Pupil-dilated.
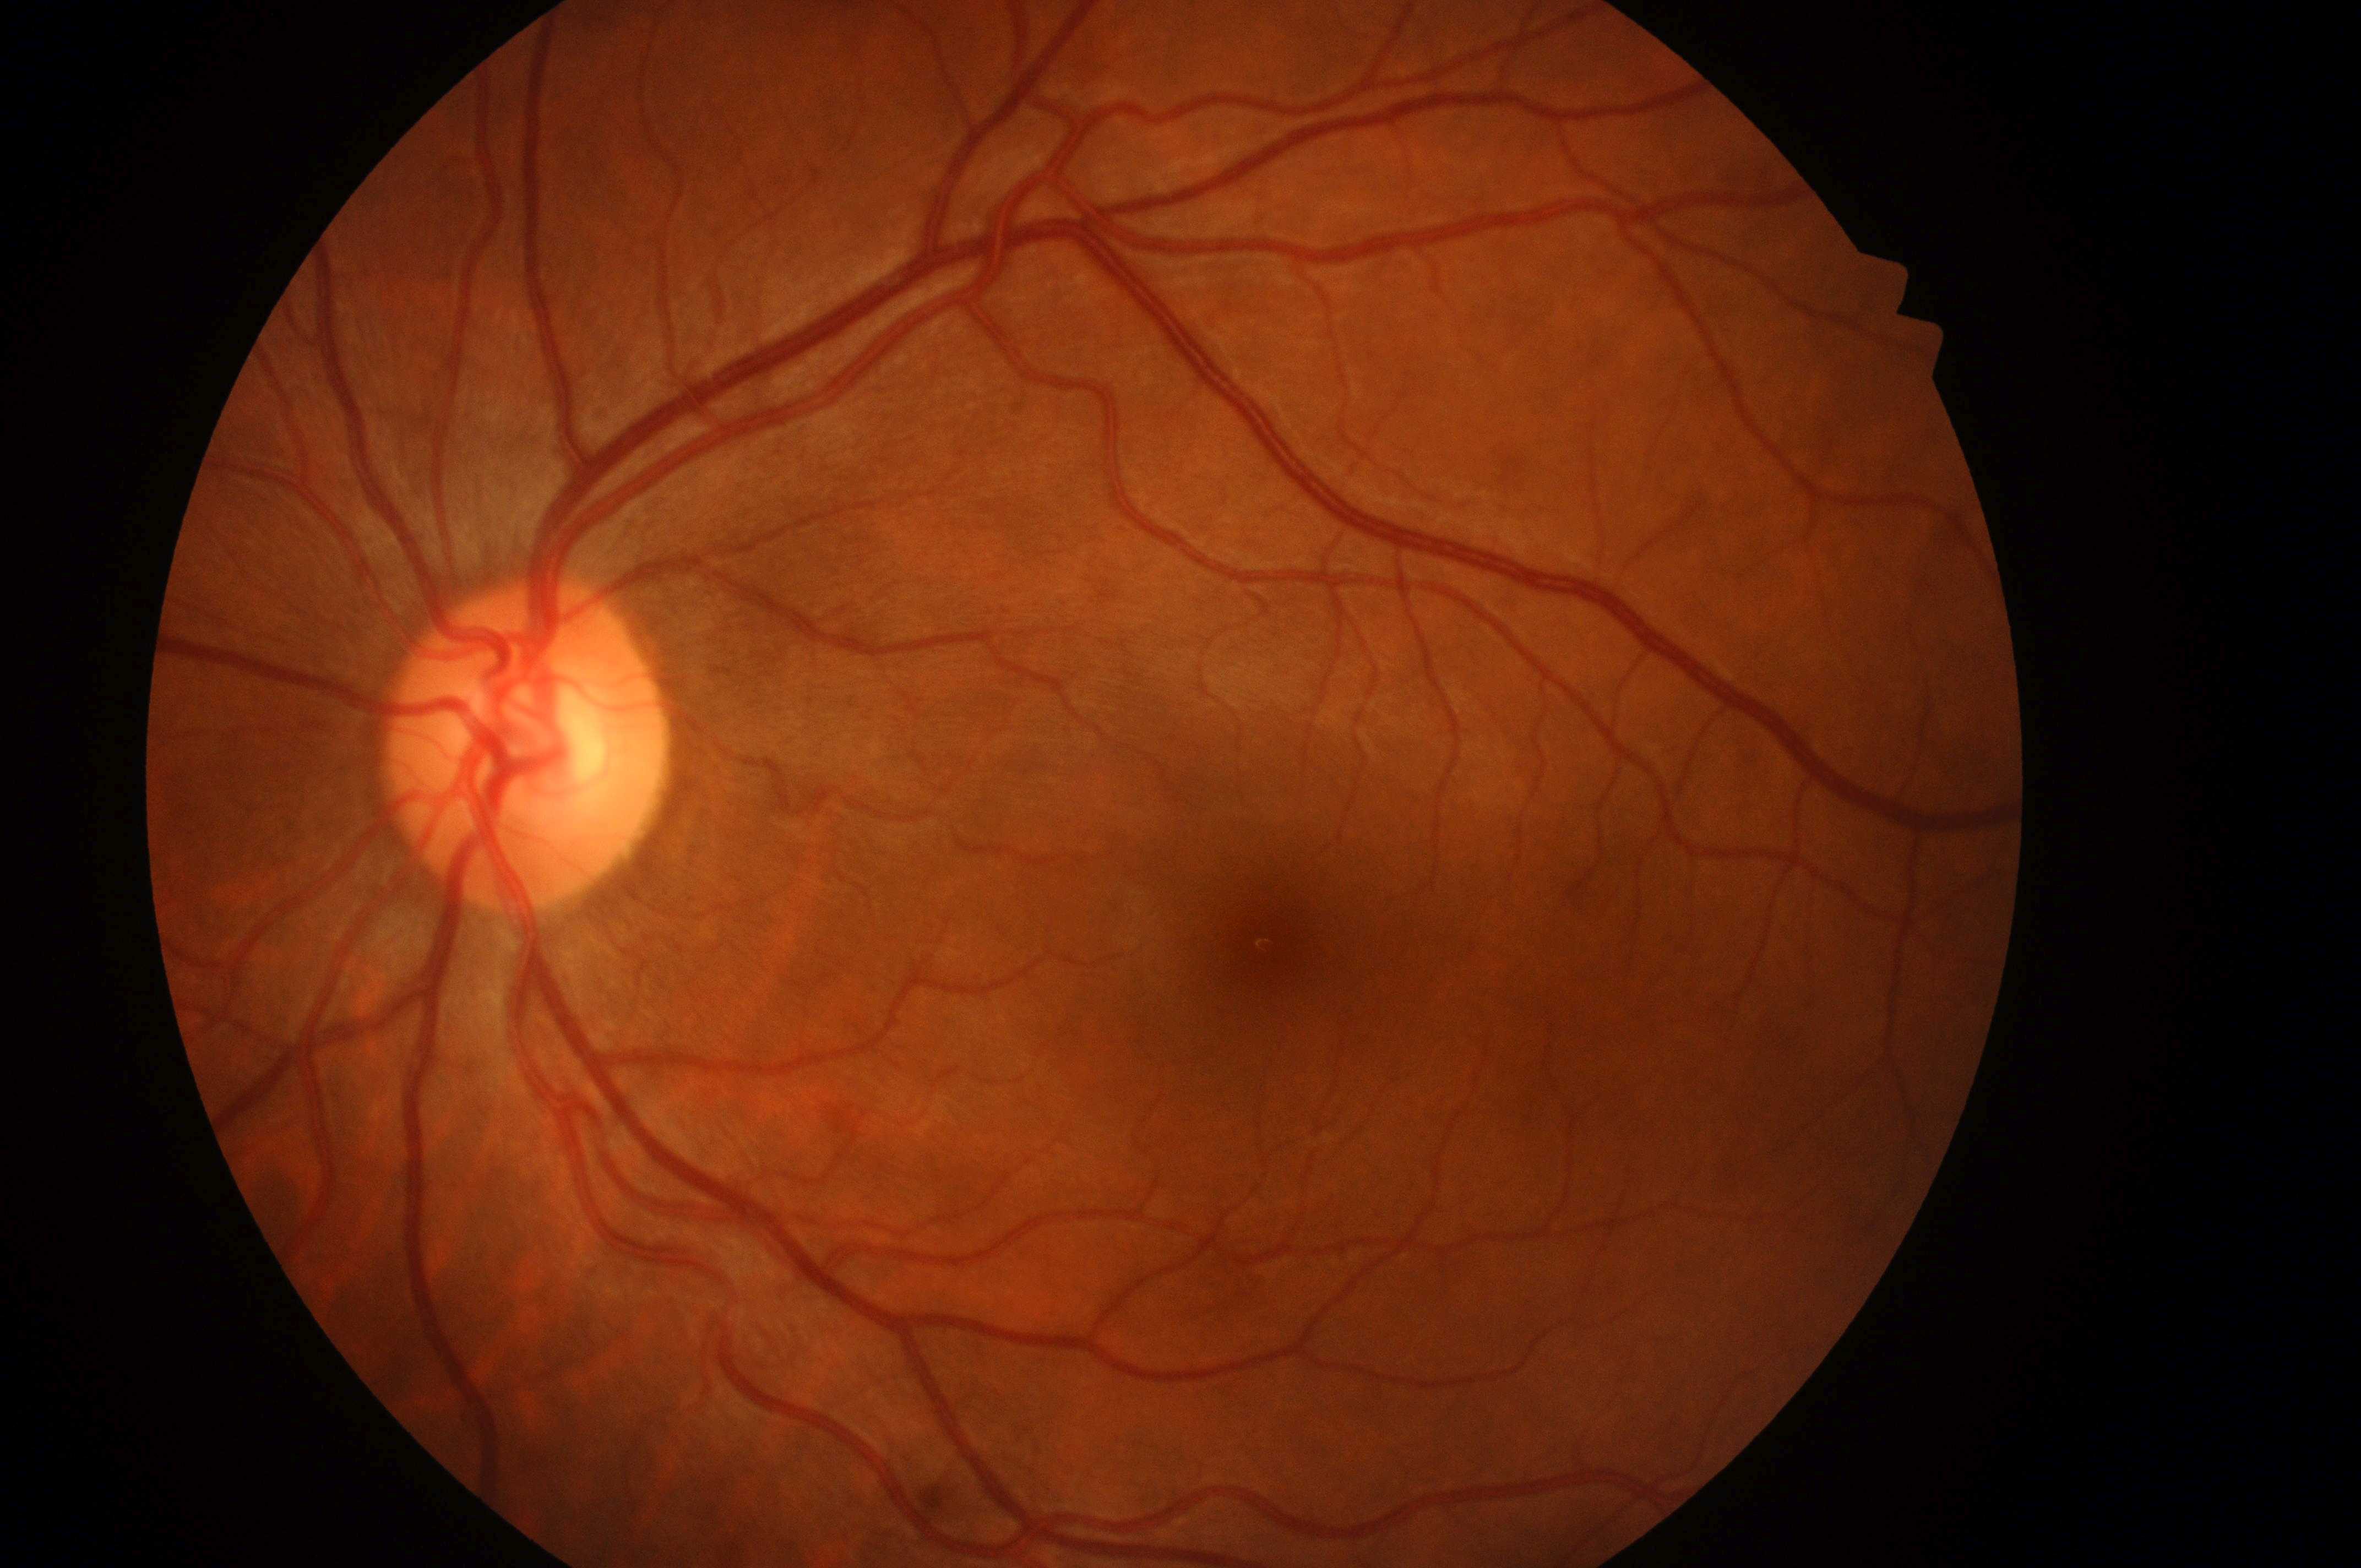
risk of macular edema = grade 0 (no risk); laterality = oculus sinister; optic disc center = [518, 759]; fovea centralis = [1277, 946]; DR impression = No diabetic retinal disease findings; retinopathy grade = no apparent diabetic retinopathy (0).